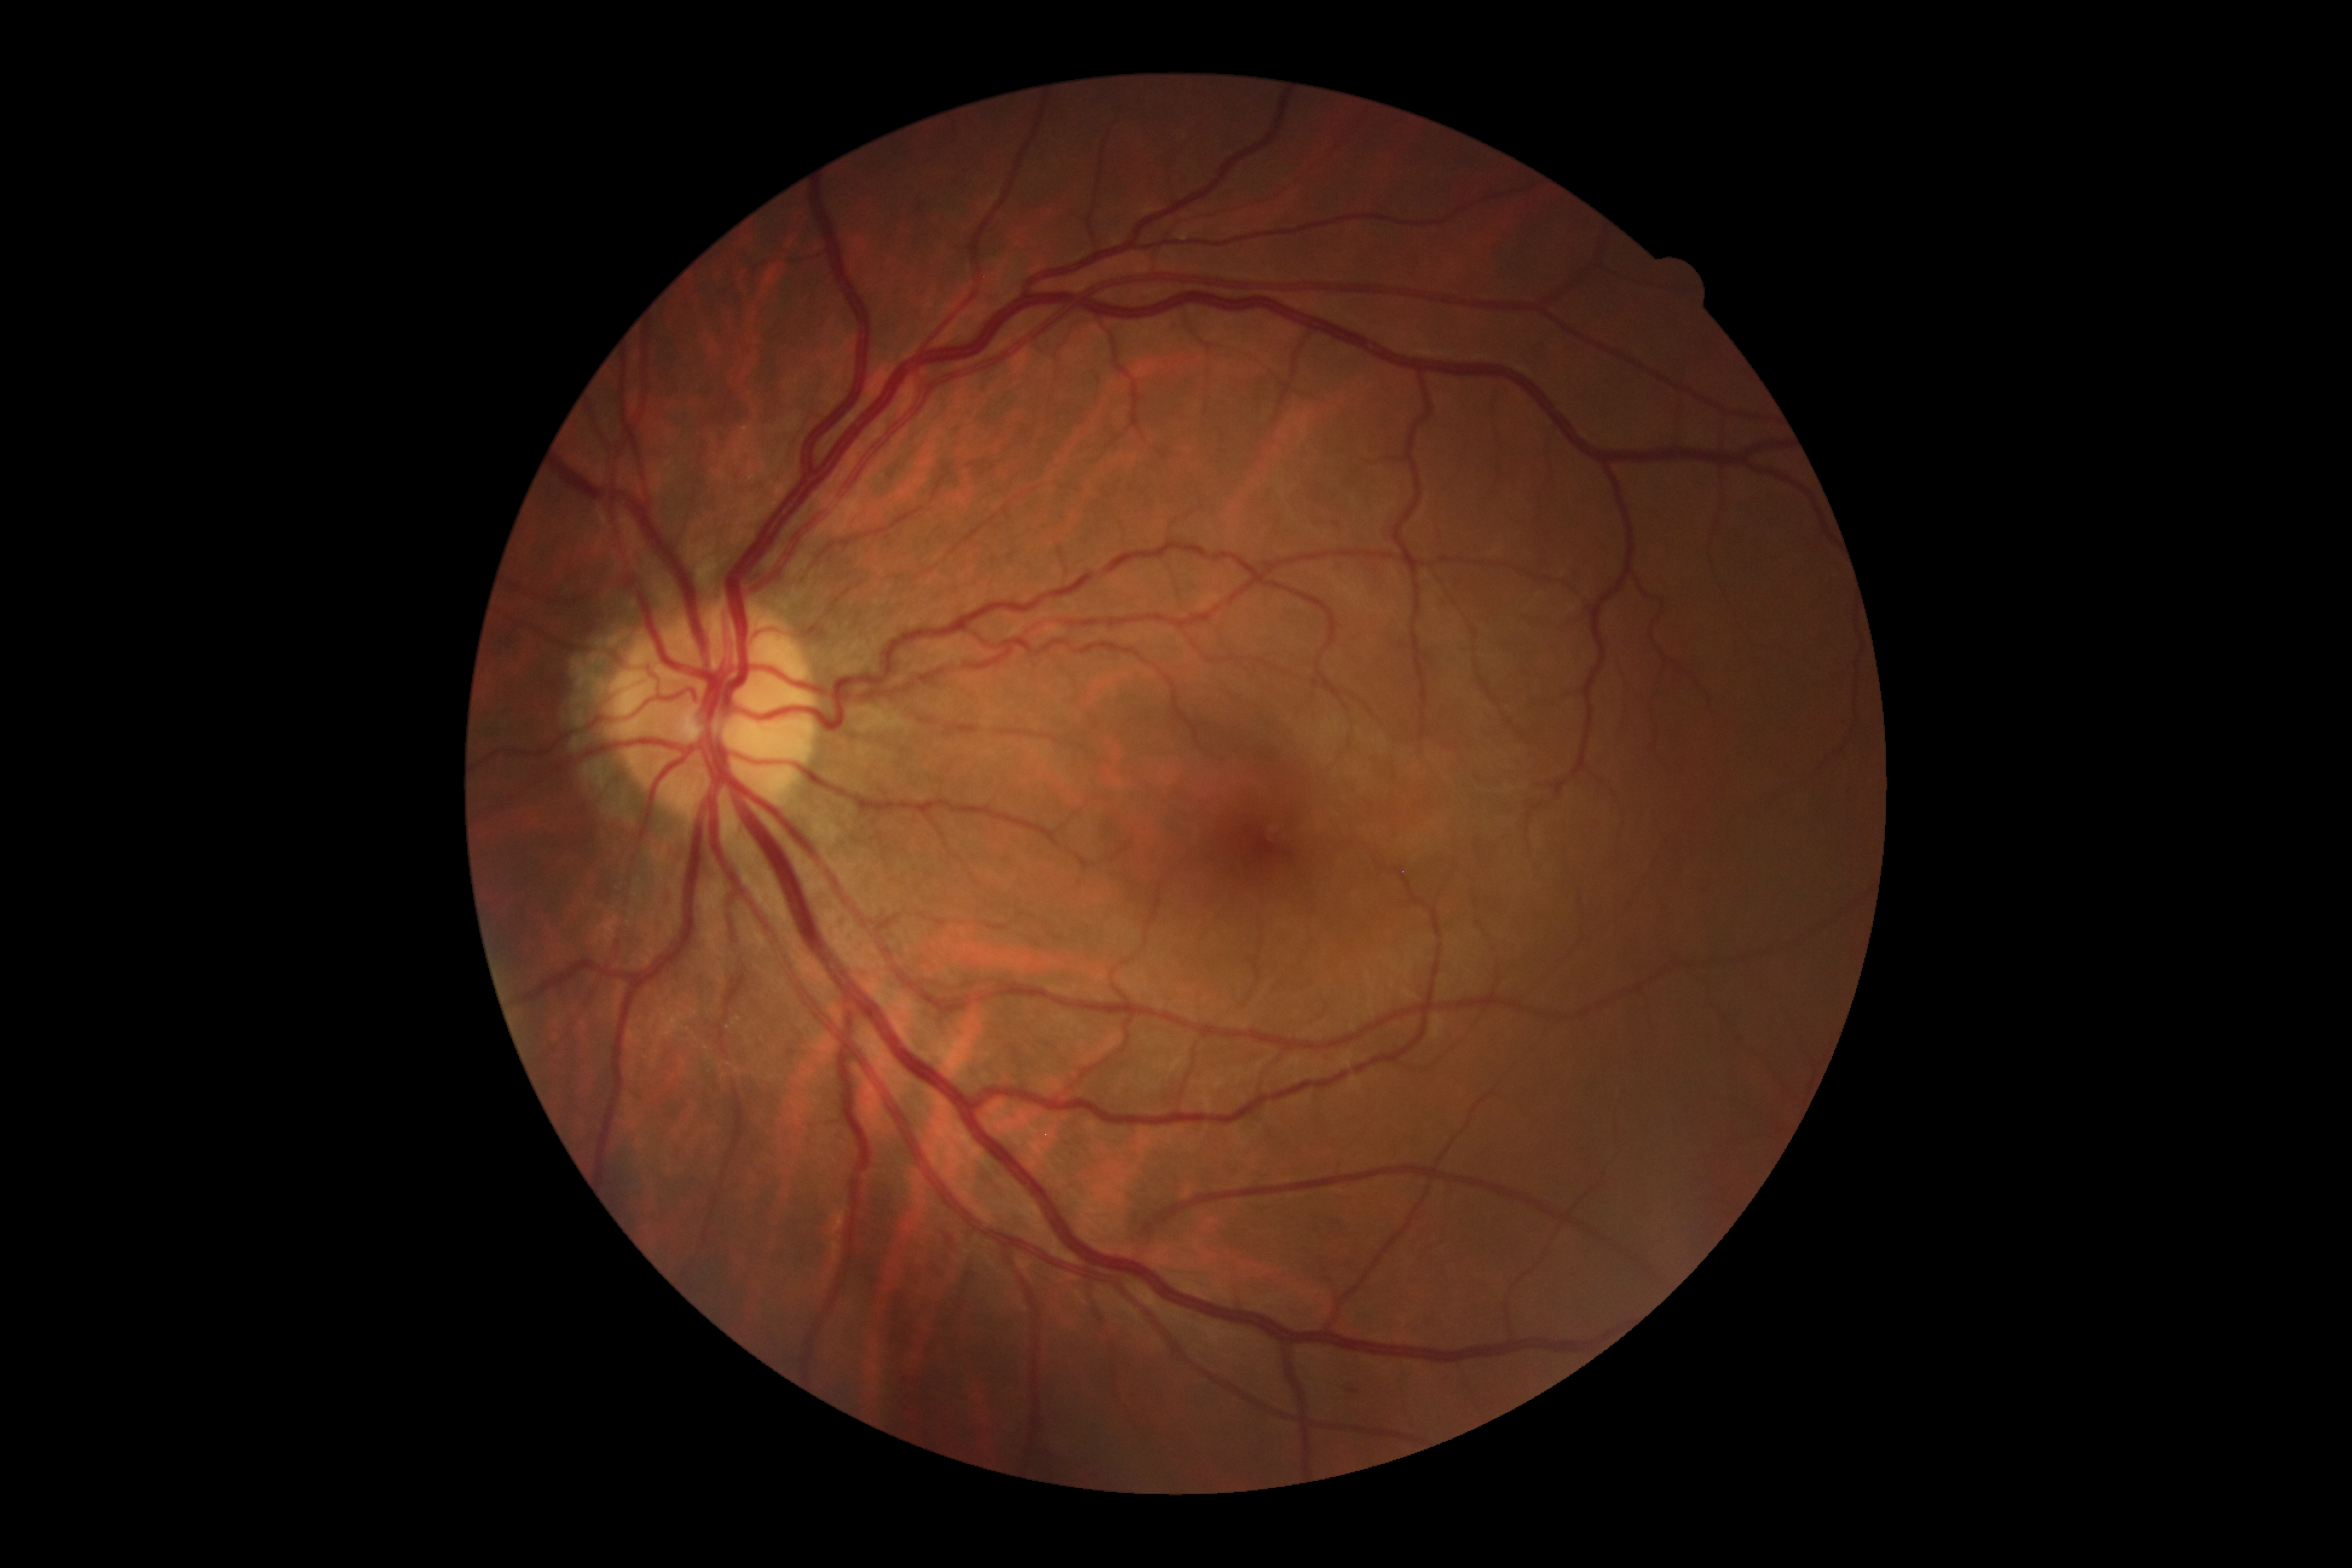 DR grade: moderate NPDR (2).